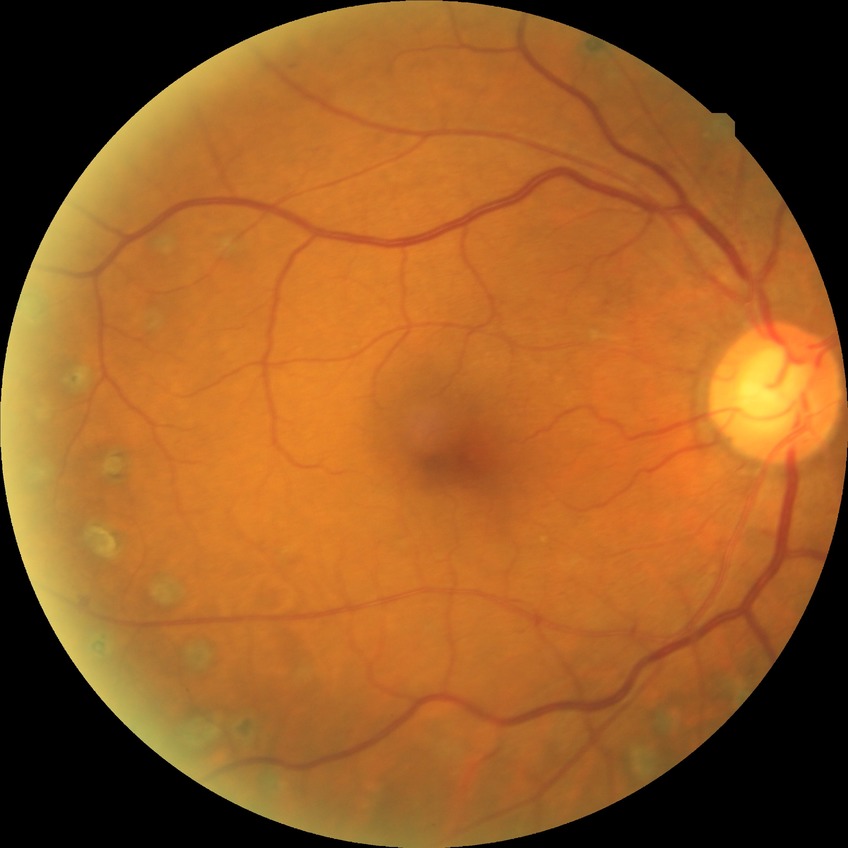
Davis grade = PDR.